Posterior pole color fundus photograph. Image size 848x848. 45 degree fundus photograph — 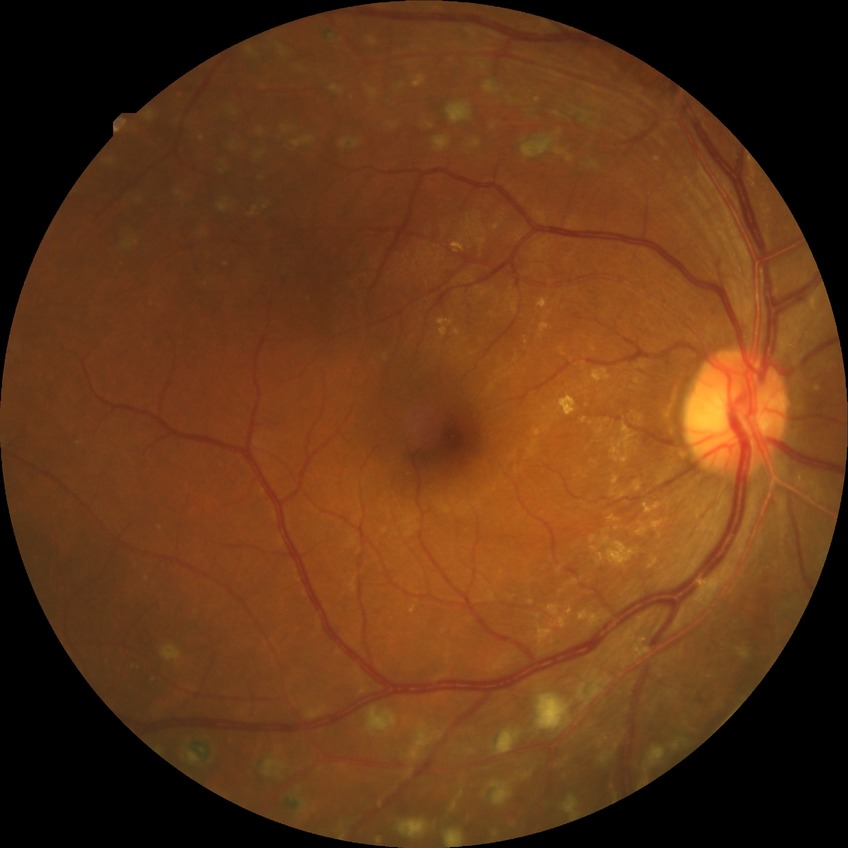
Diabetic retinopathy (DR) is PDR (proliferative diabetic retinopathy).